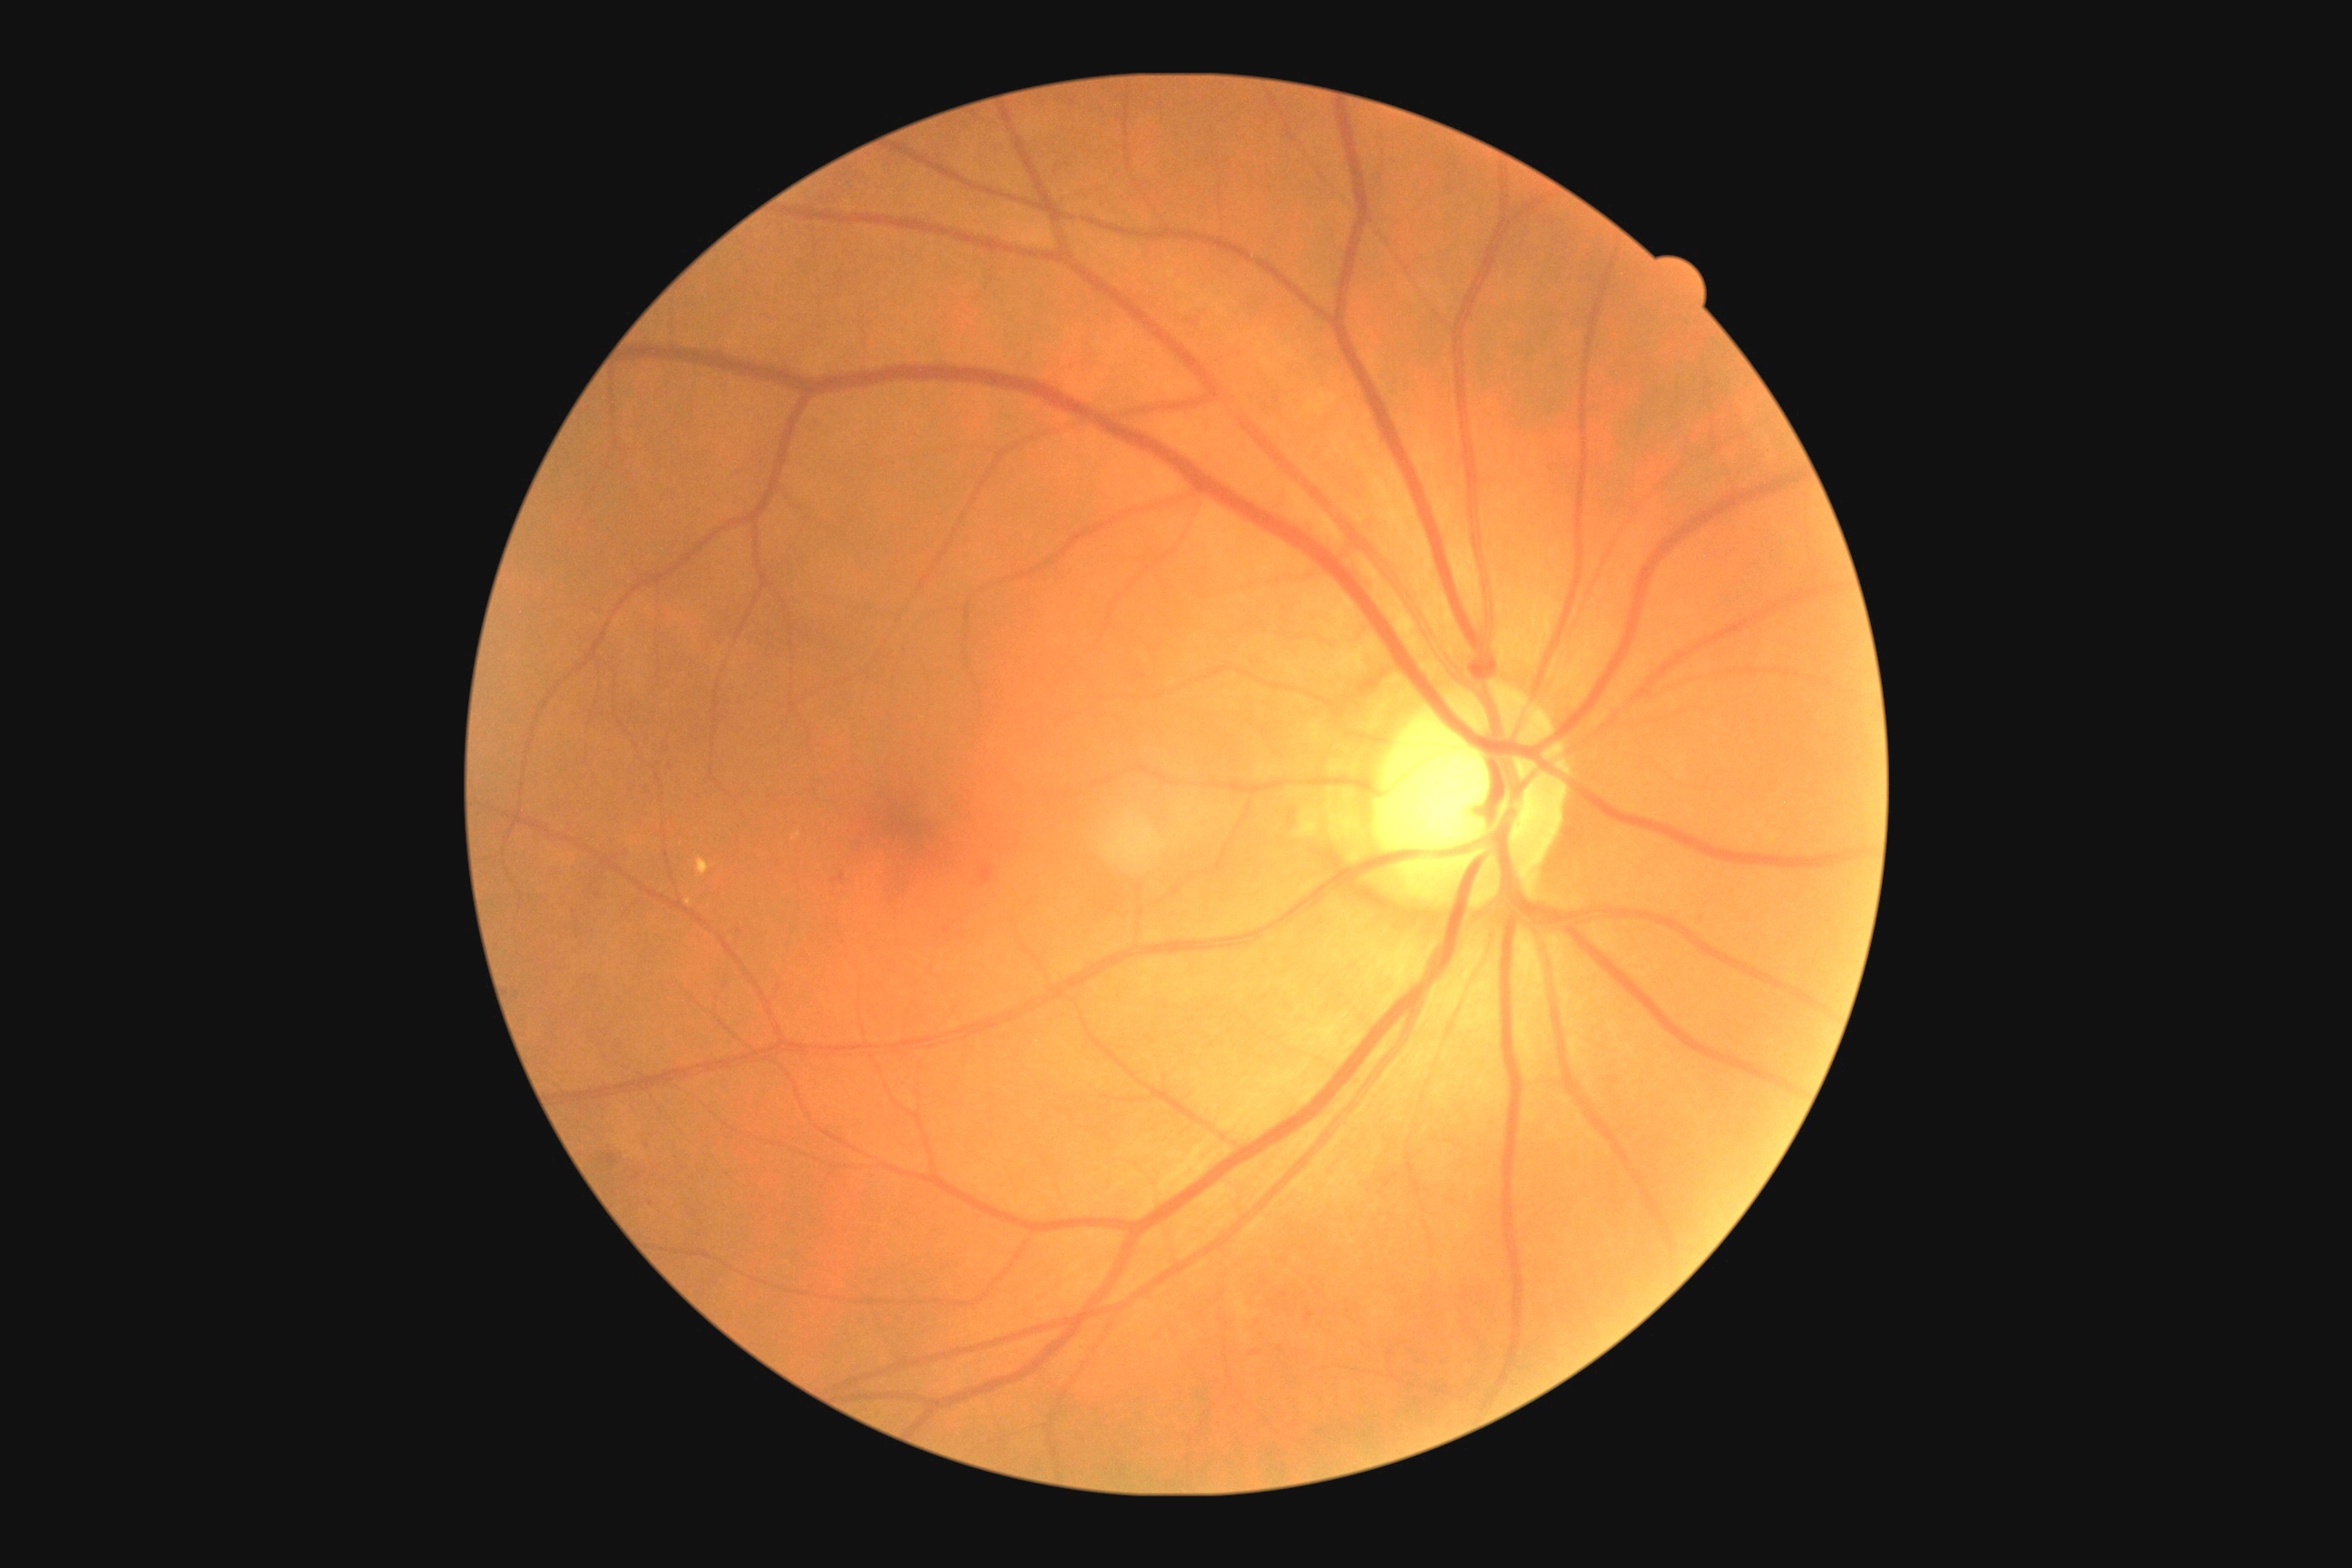

Findings:
– DR — grade 2 (moderate NPDR)